Camera: Topcon TRC-50DX, image size 2228x1652, field includes the optic disc and macula, mydriatic (tropicamide and phenylephrine), CFP
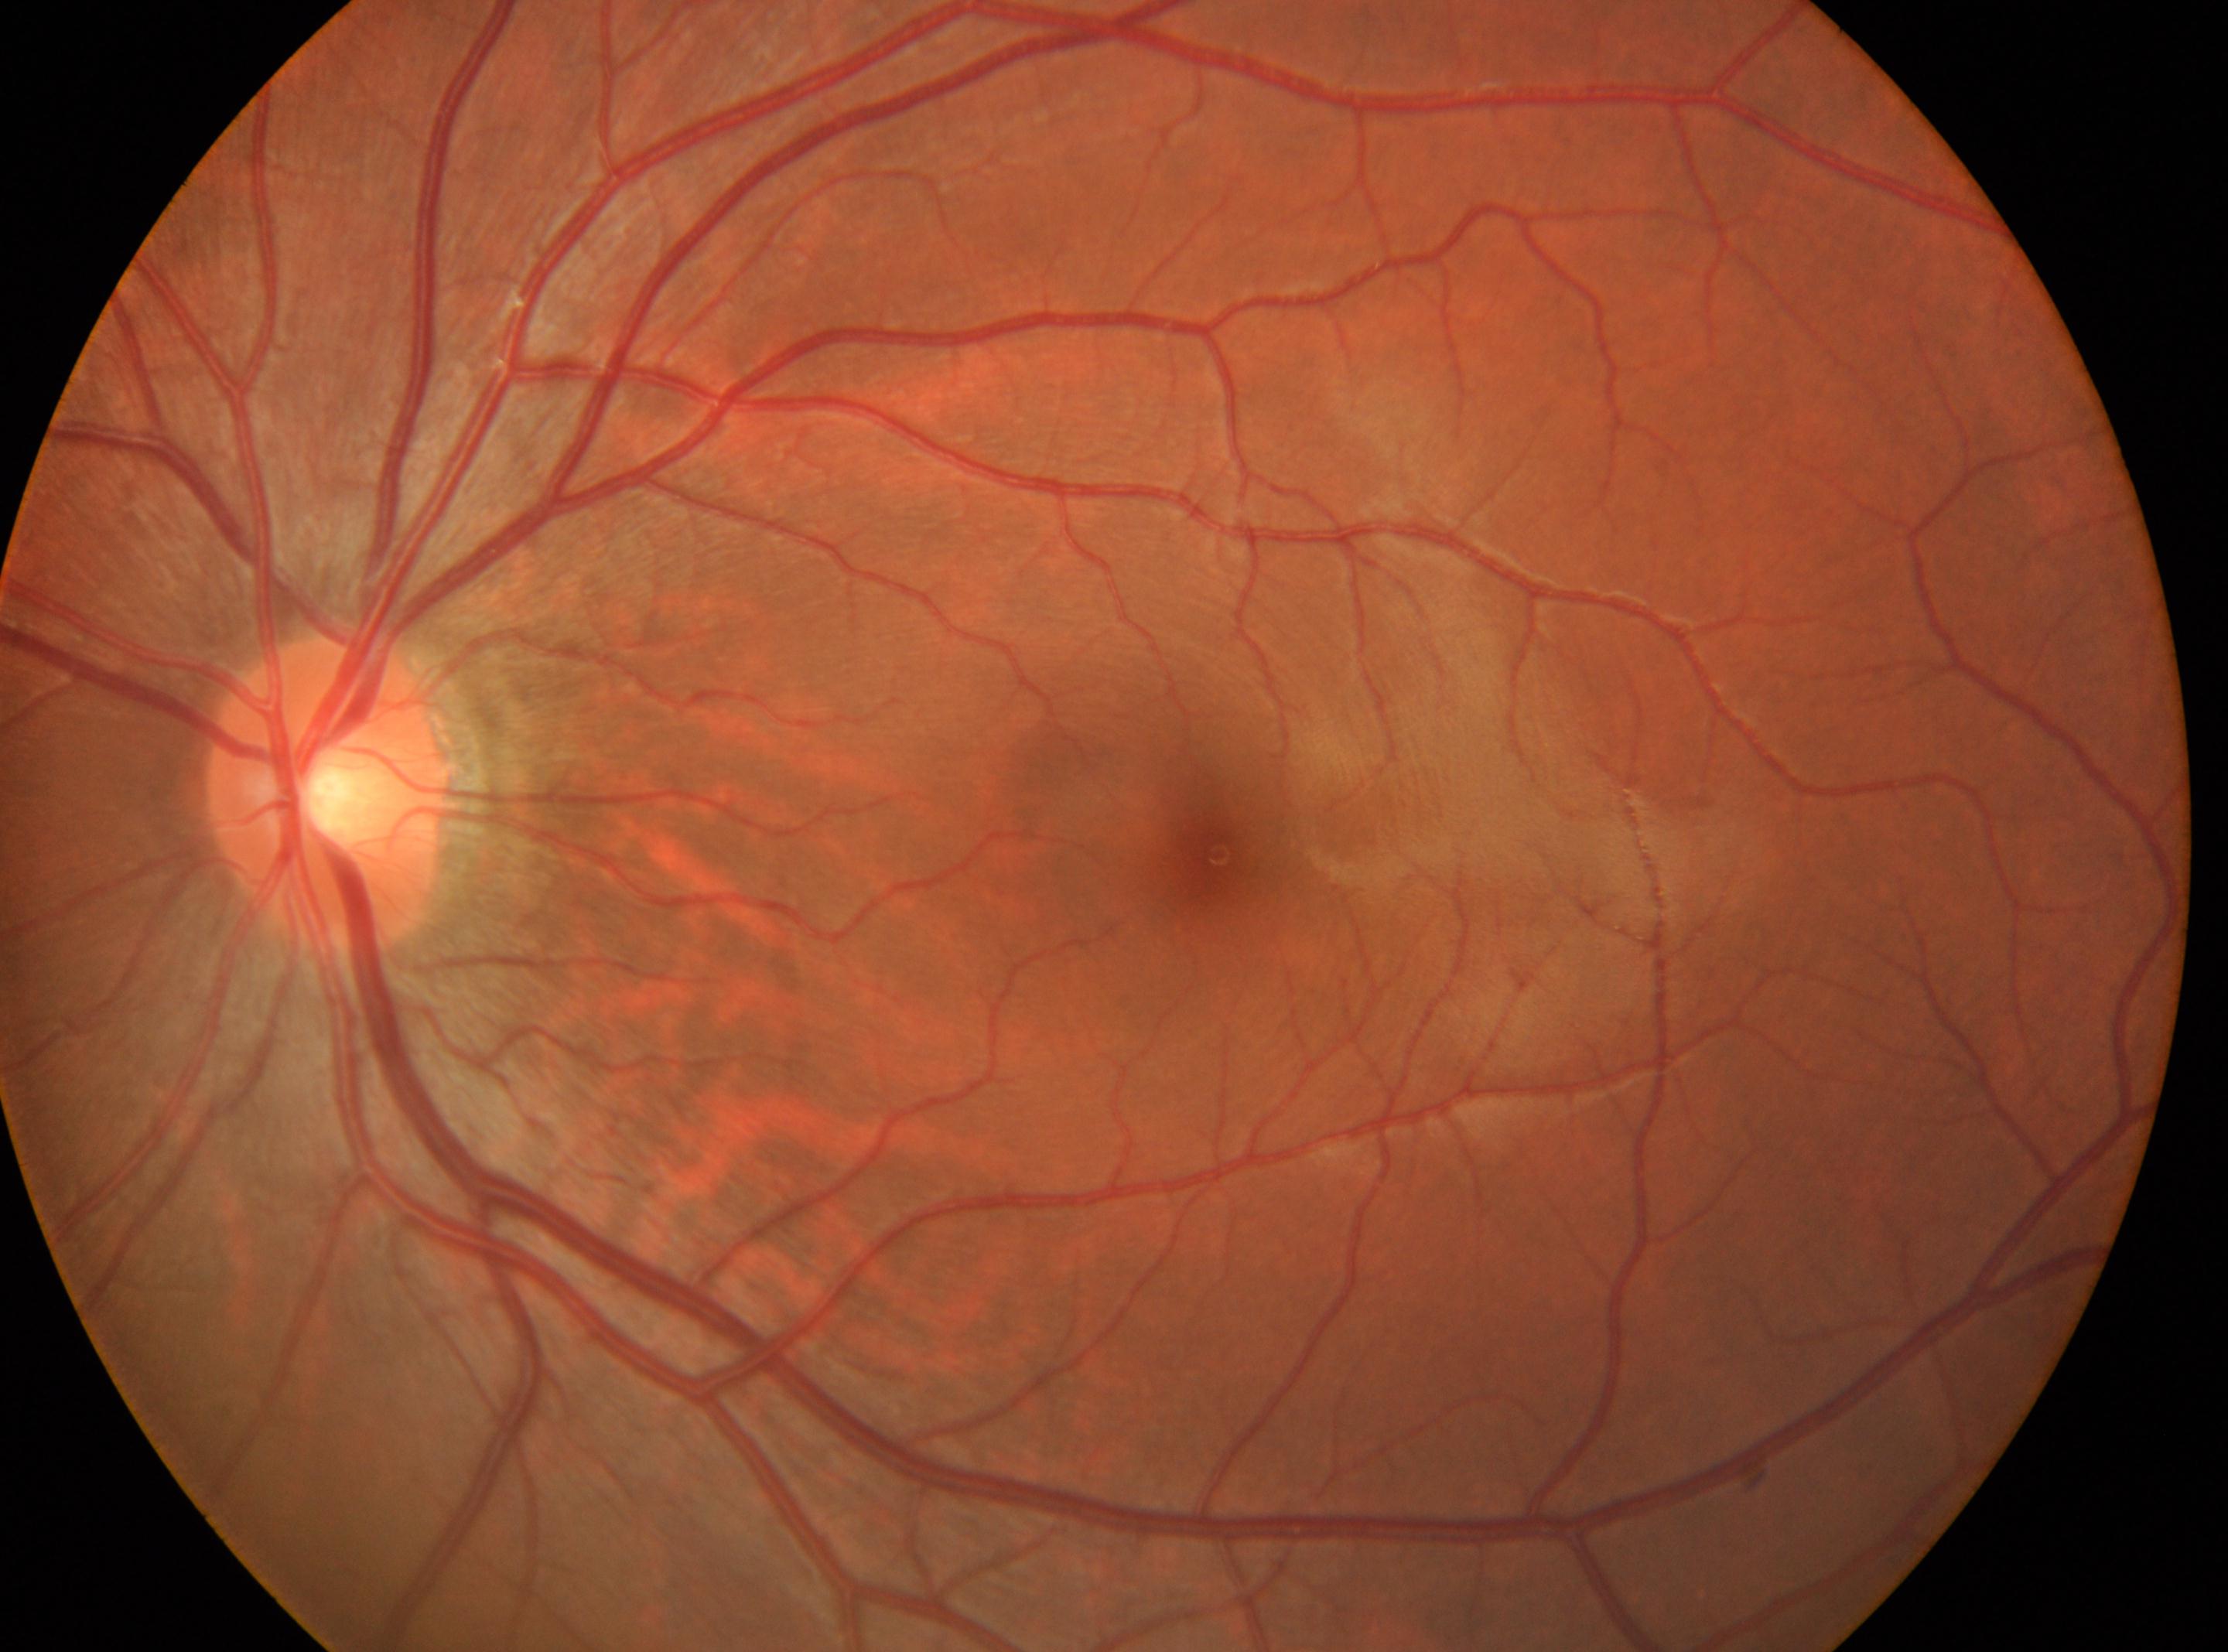 Diabetic retinopathy (DR): 0.
Eye: left eye.
ONH: [325, 790].
Foveal center: [1218, 854].